Acquired on the Phoenix ICON; Phoenix ICON wide-field infant fundus image; 1240x1240:
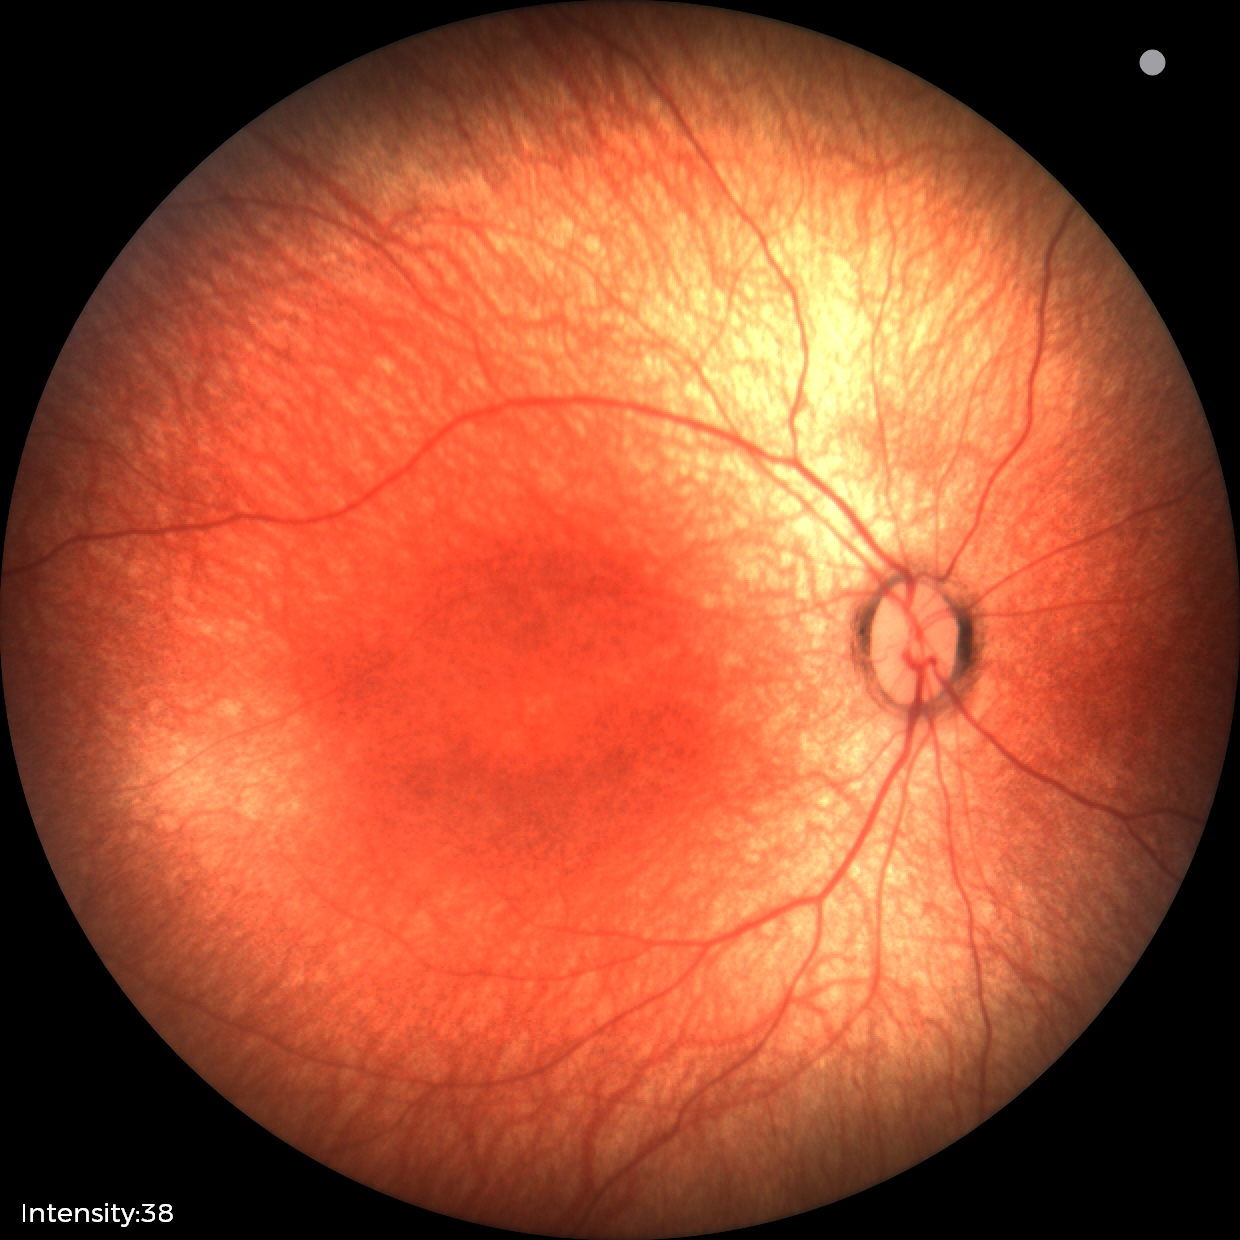
Screening examination diagnosed as physiological.